FOV: 45 degrees
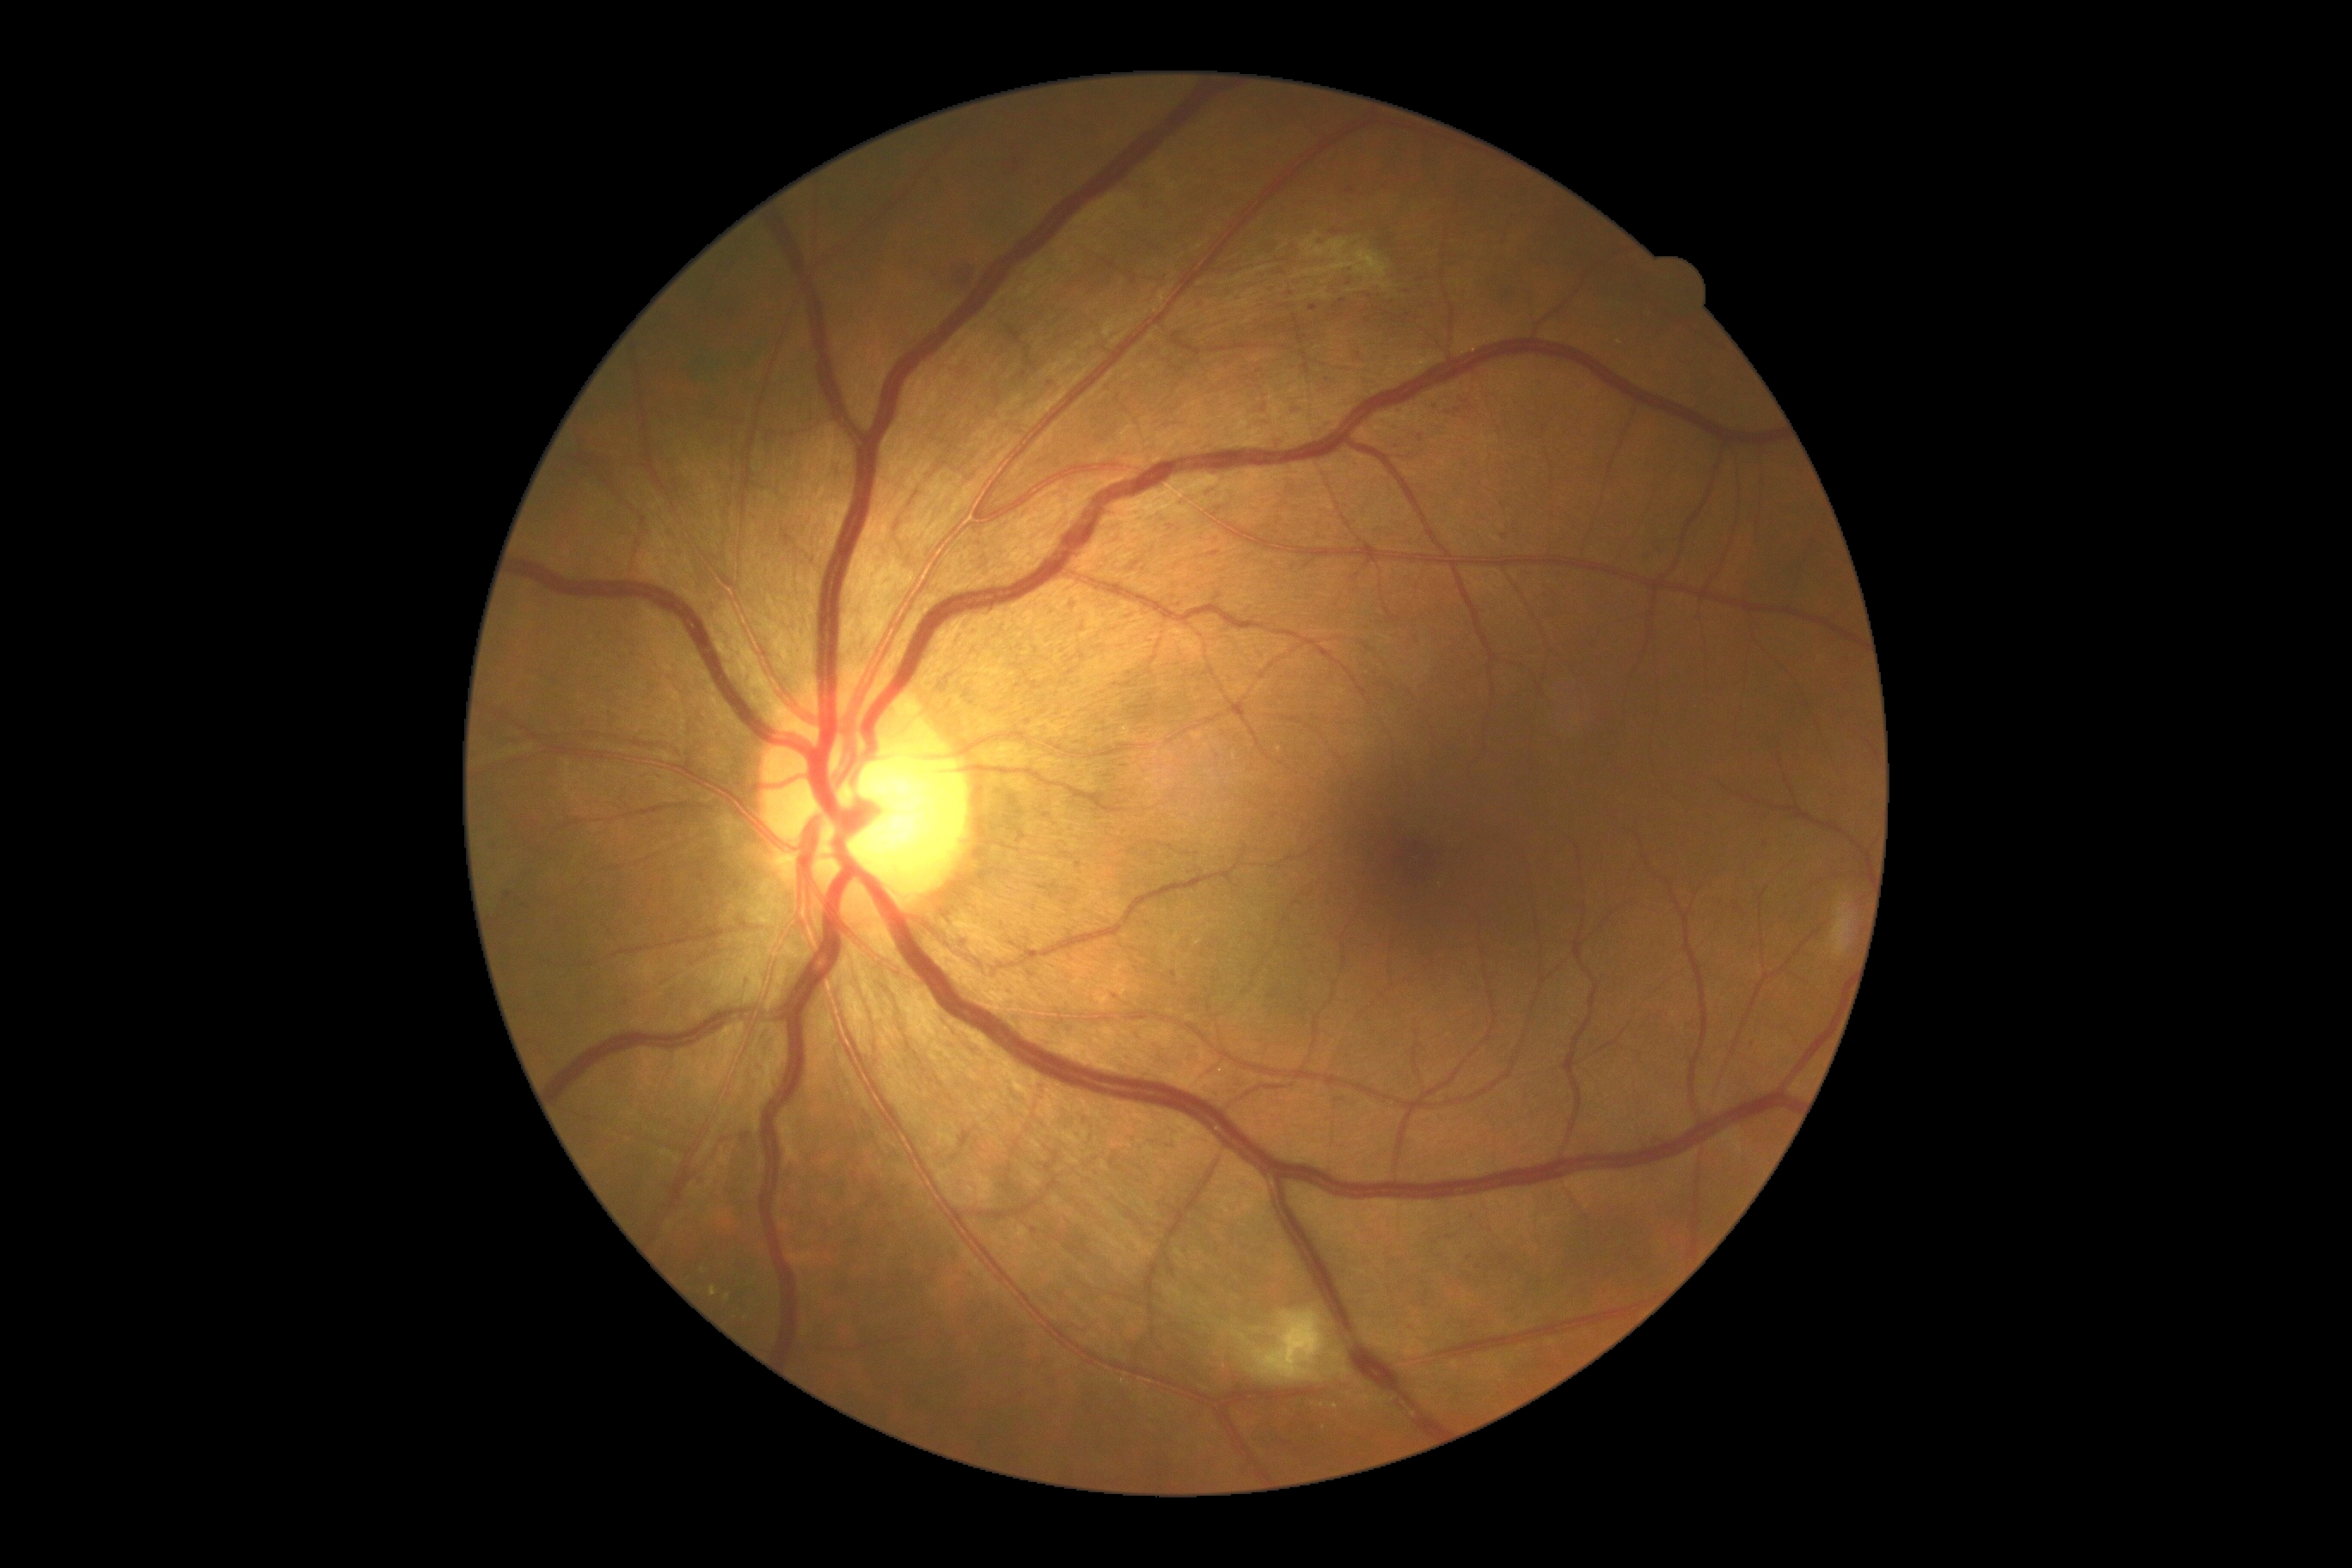
Diabetic retinopathy severity: severe non-proliferative diabetic retinopathy (grade 3).